Optic disc region crop — 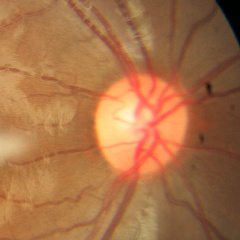 Q: What is the glaucoma diagnosis?
A: No glaucoma.